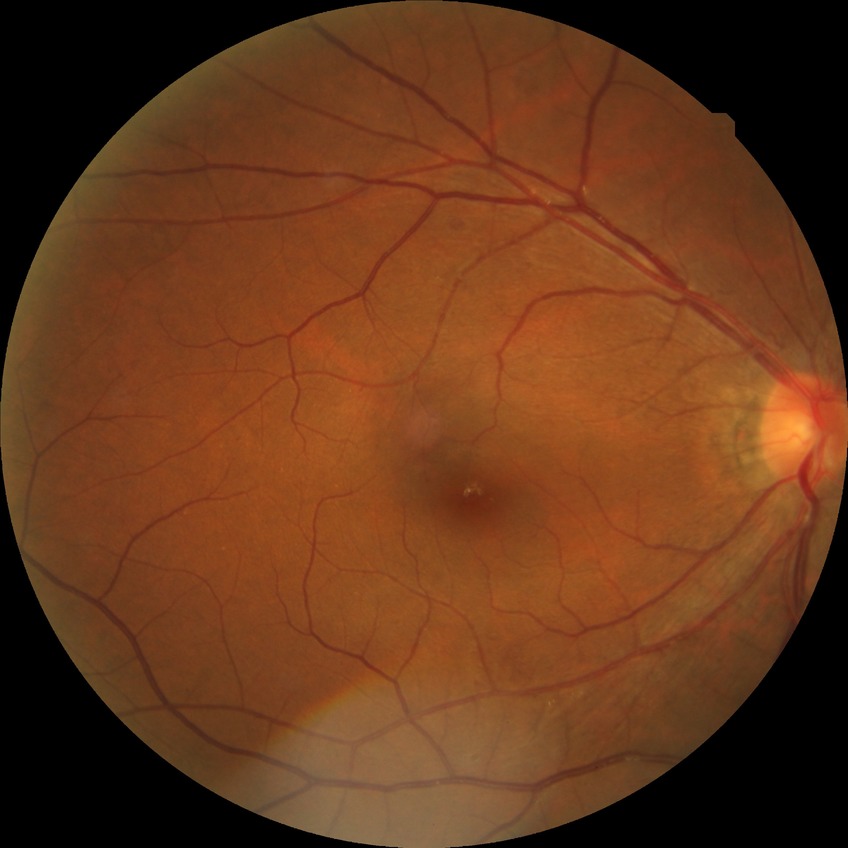

Diabetic retinopathy (DR): simple diabetic retinopathy (SDR).